Image size 848x848.
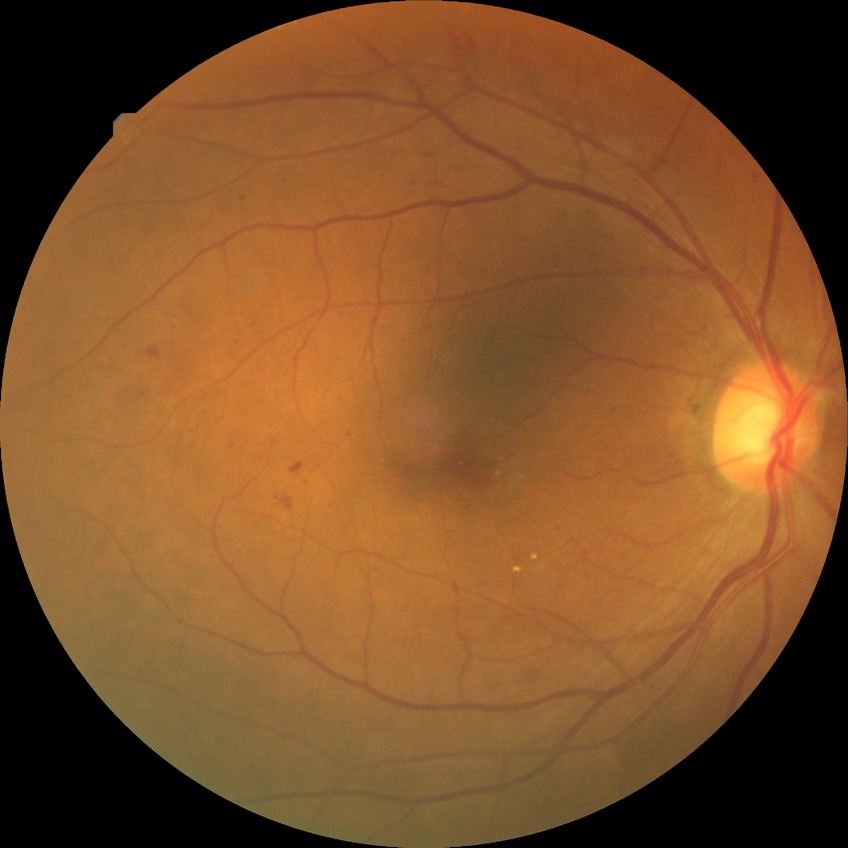

Davis grading: simple diabetic retinopathy. DR class: non-proliferative diabetic retinopathy.